Fundus photo: 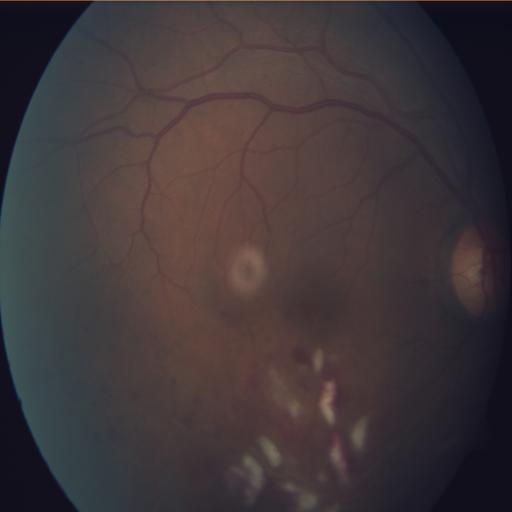 Findings: media haze | cotton wool spots.